45-degree field of view. Color fundus image. 2352x1568:
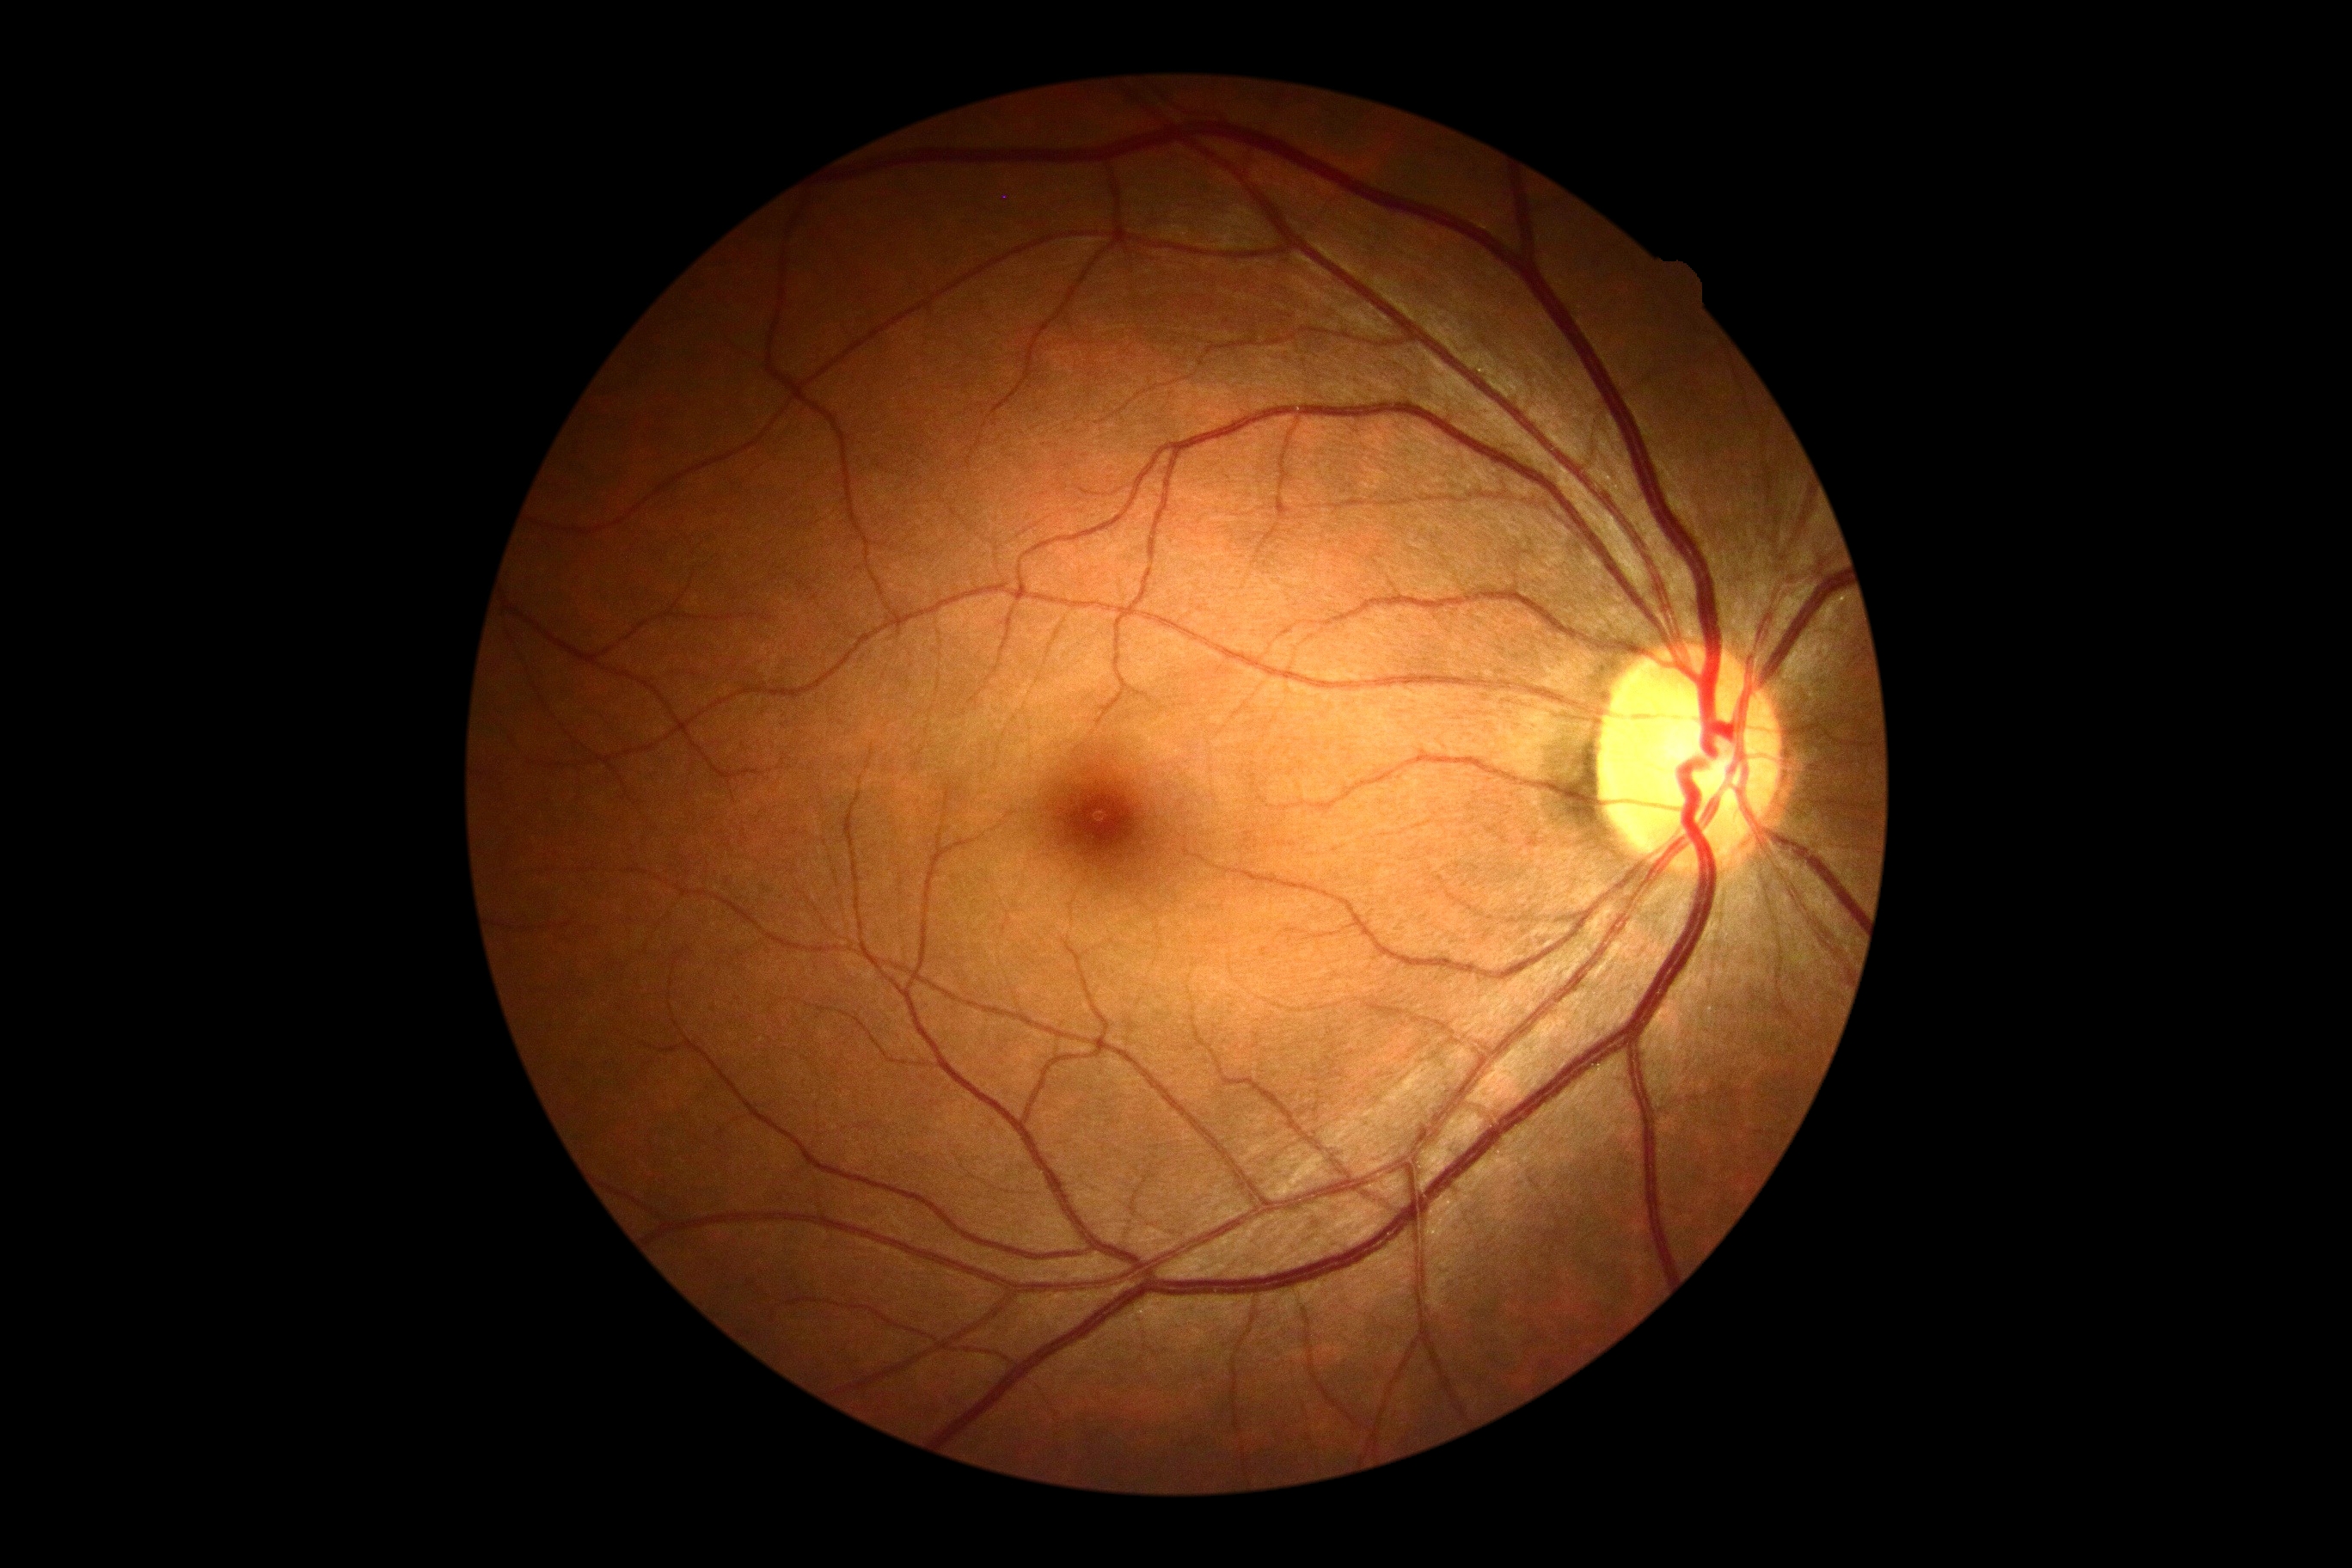 DR impression@no apparent DR; diabetic retinopathy (DR)@no apparent diabetic retinopathy (grade 0).